Wide-field fundus photograph from neonatal ROP screening · Natus RetCam Envision, 130° FOV · 1440 by 1080 pixels:
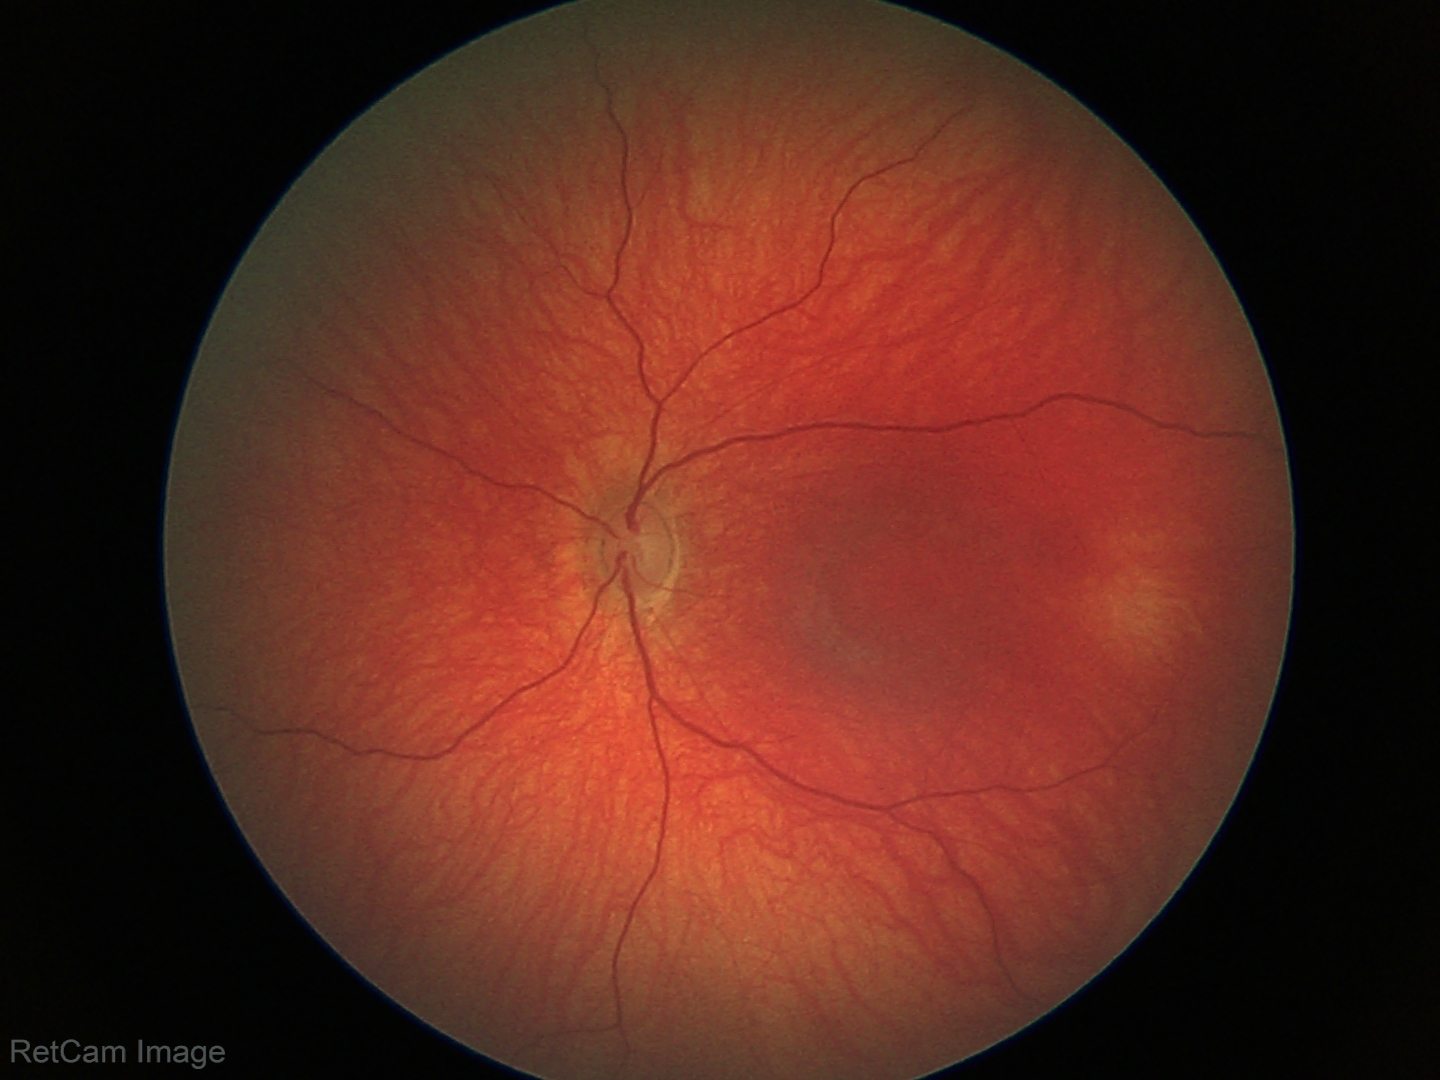 Screening: physiological finding.